CFP, 45° FOV:
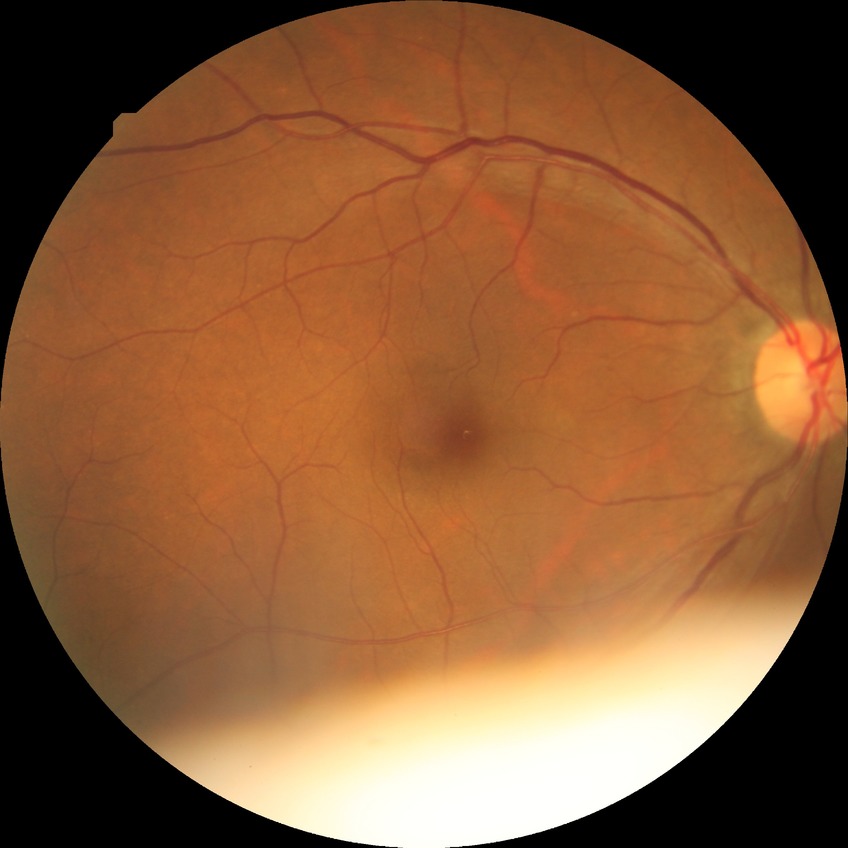
DR severity=NDR.